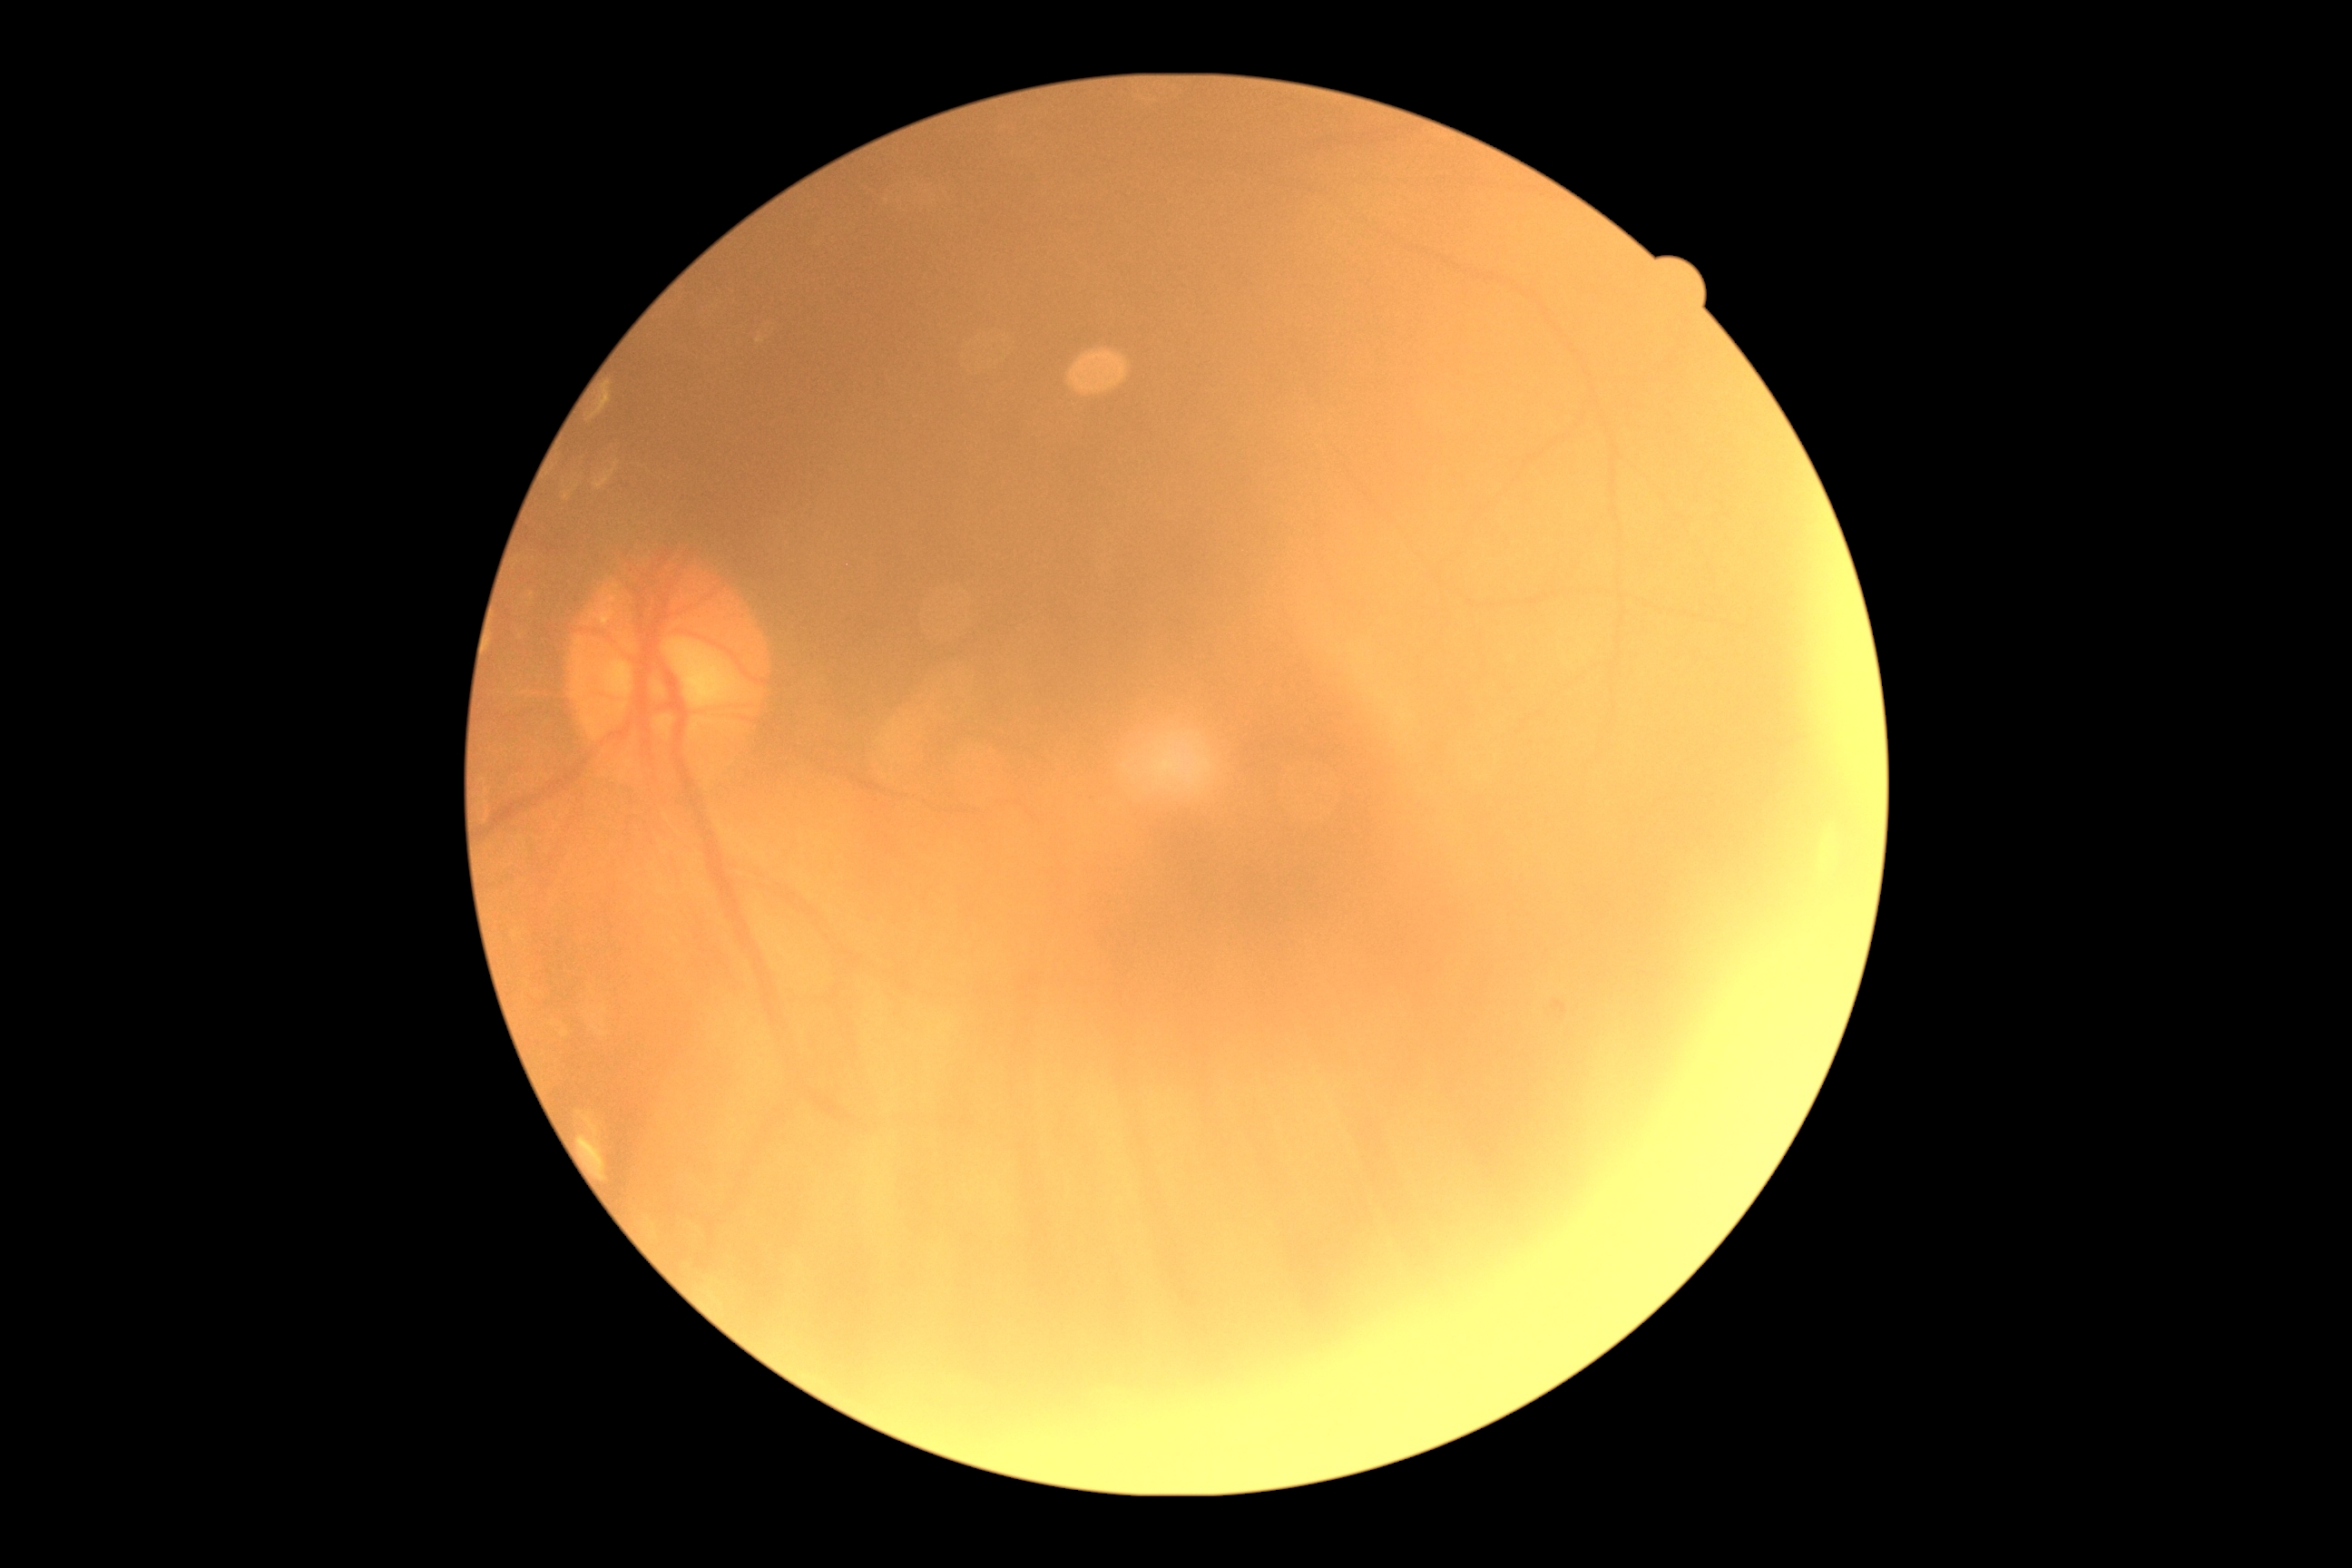

image quality: insufficient
diabetic retinopathy severity: ungradable due to poor image quality